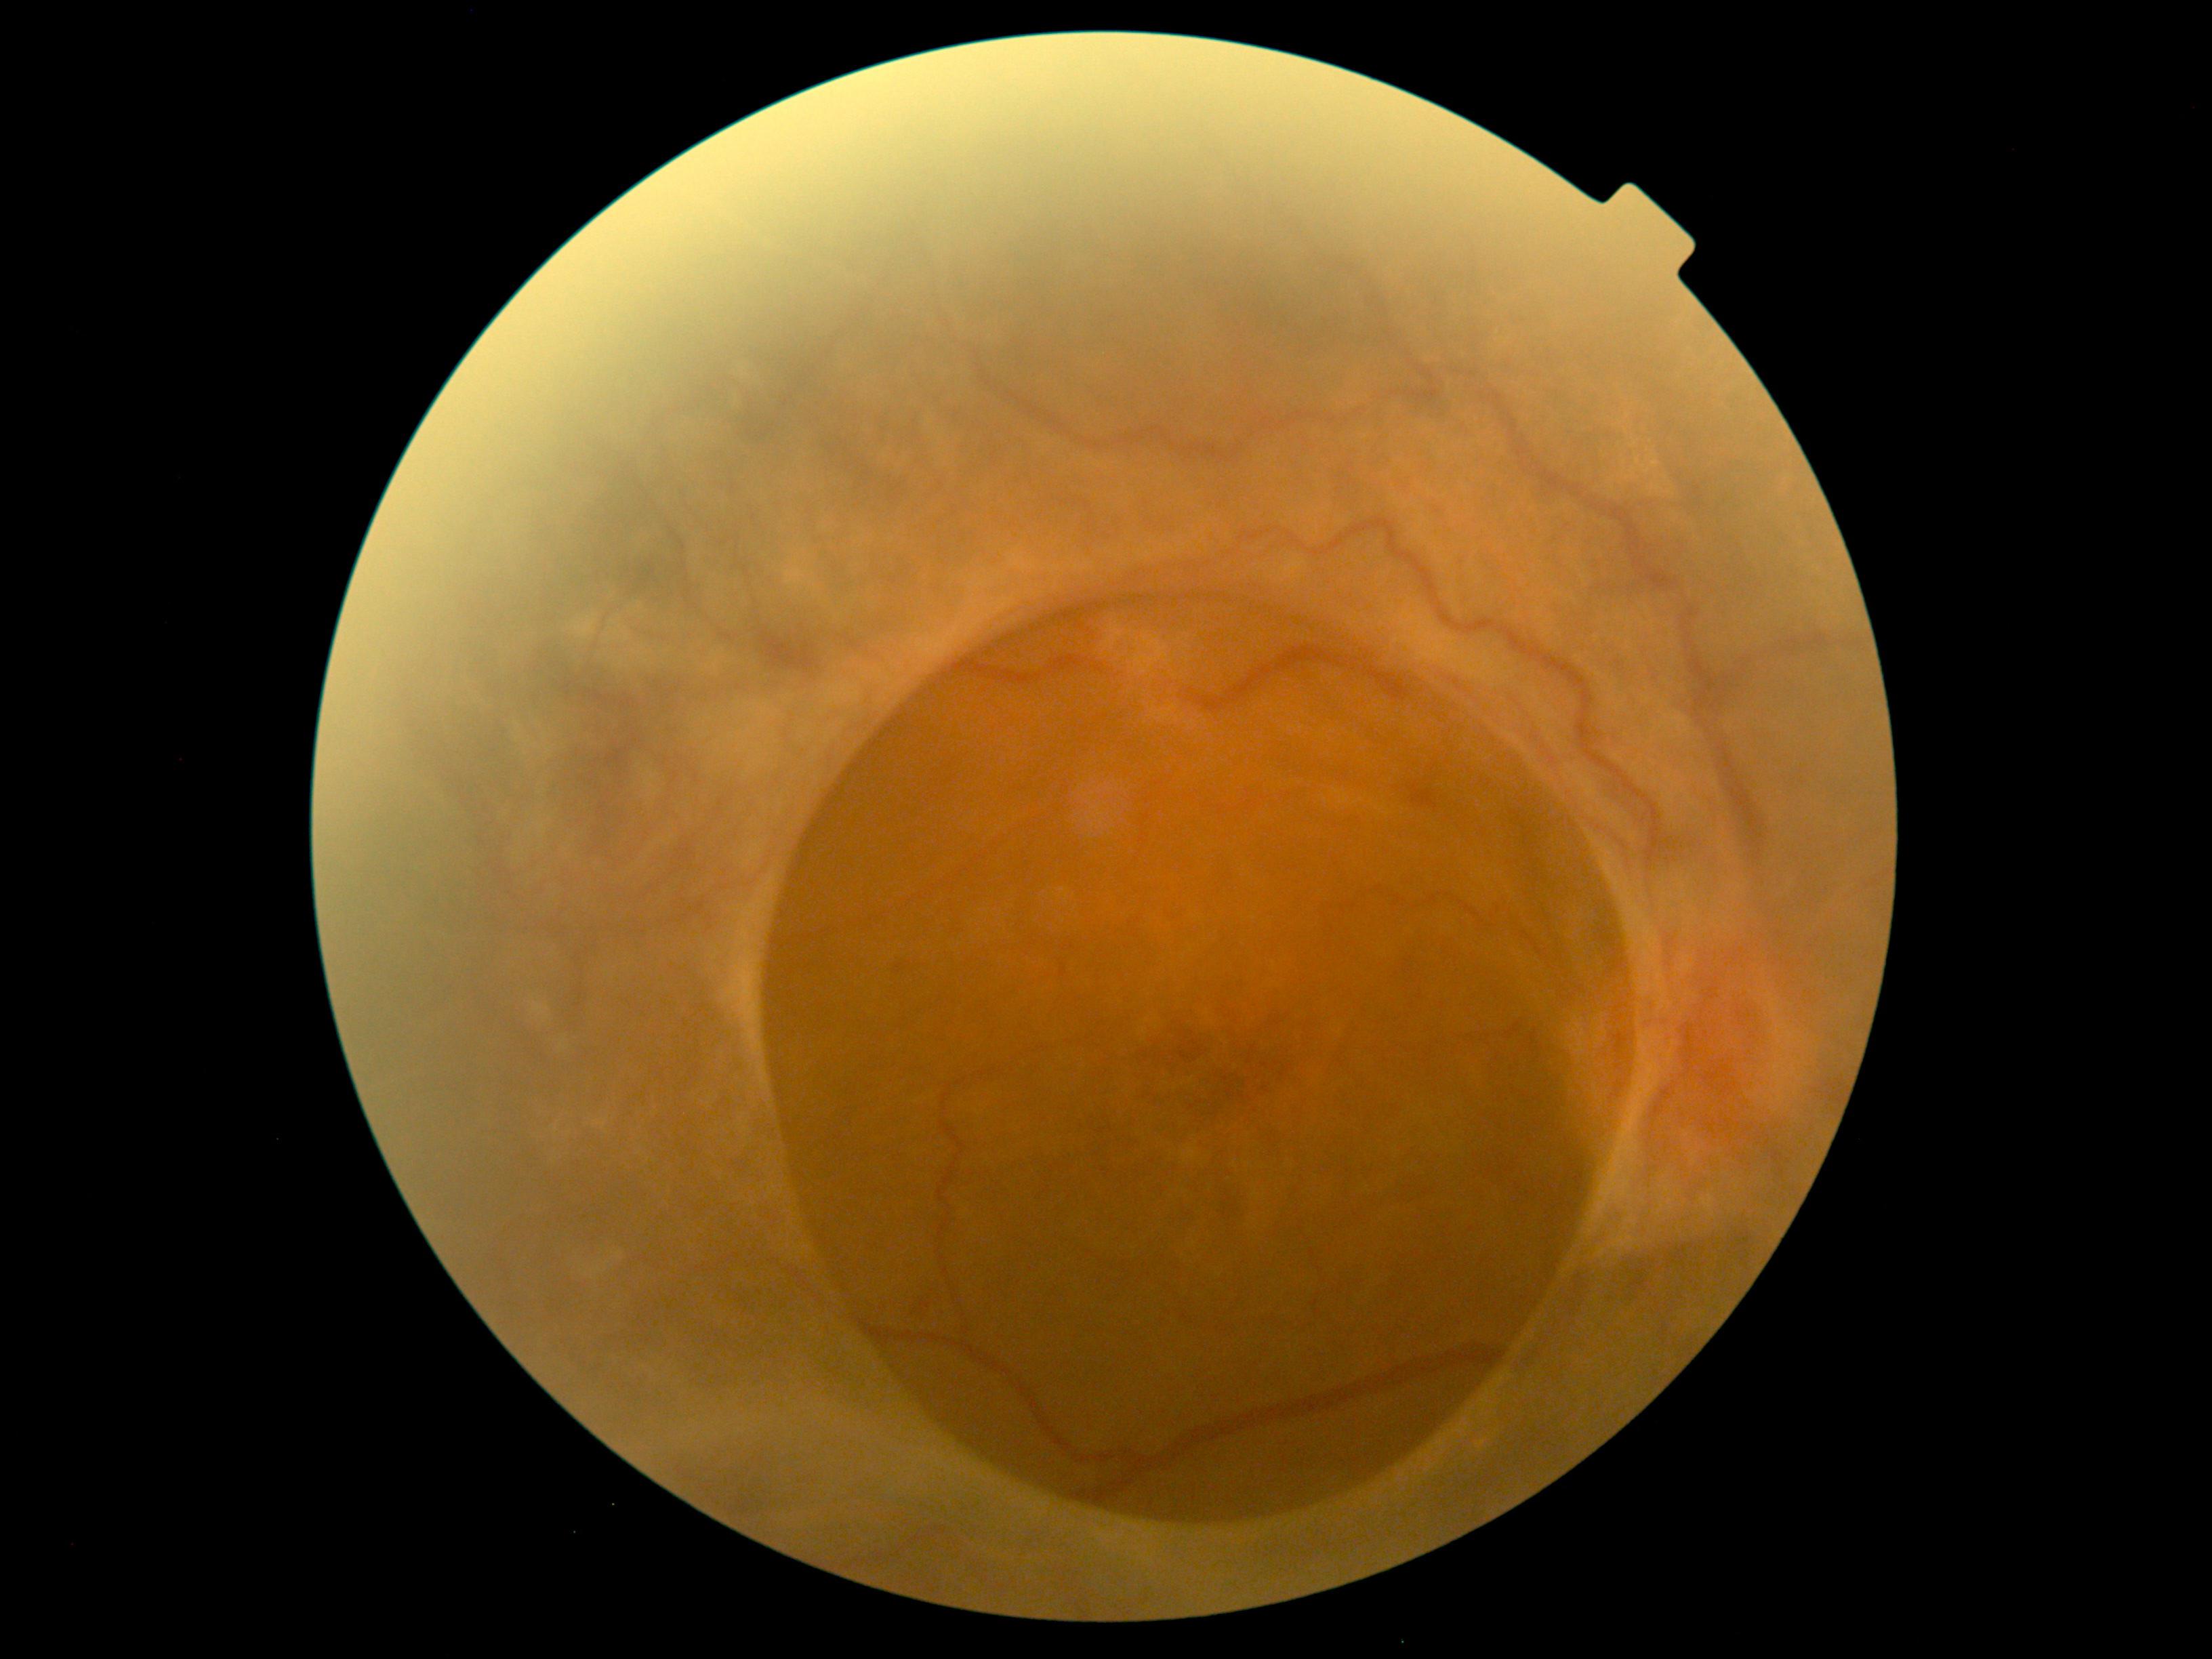 DR: 4/4.